45° field of view; color fundus image; 2048x1536
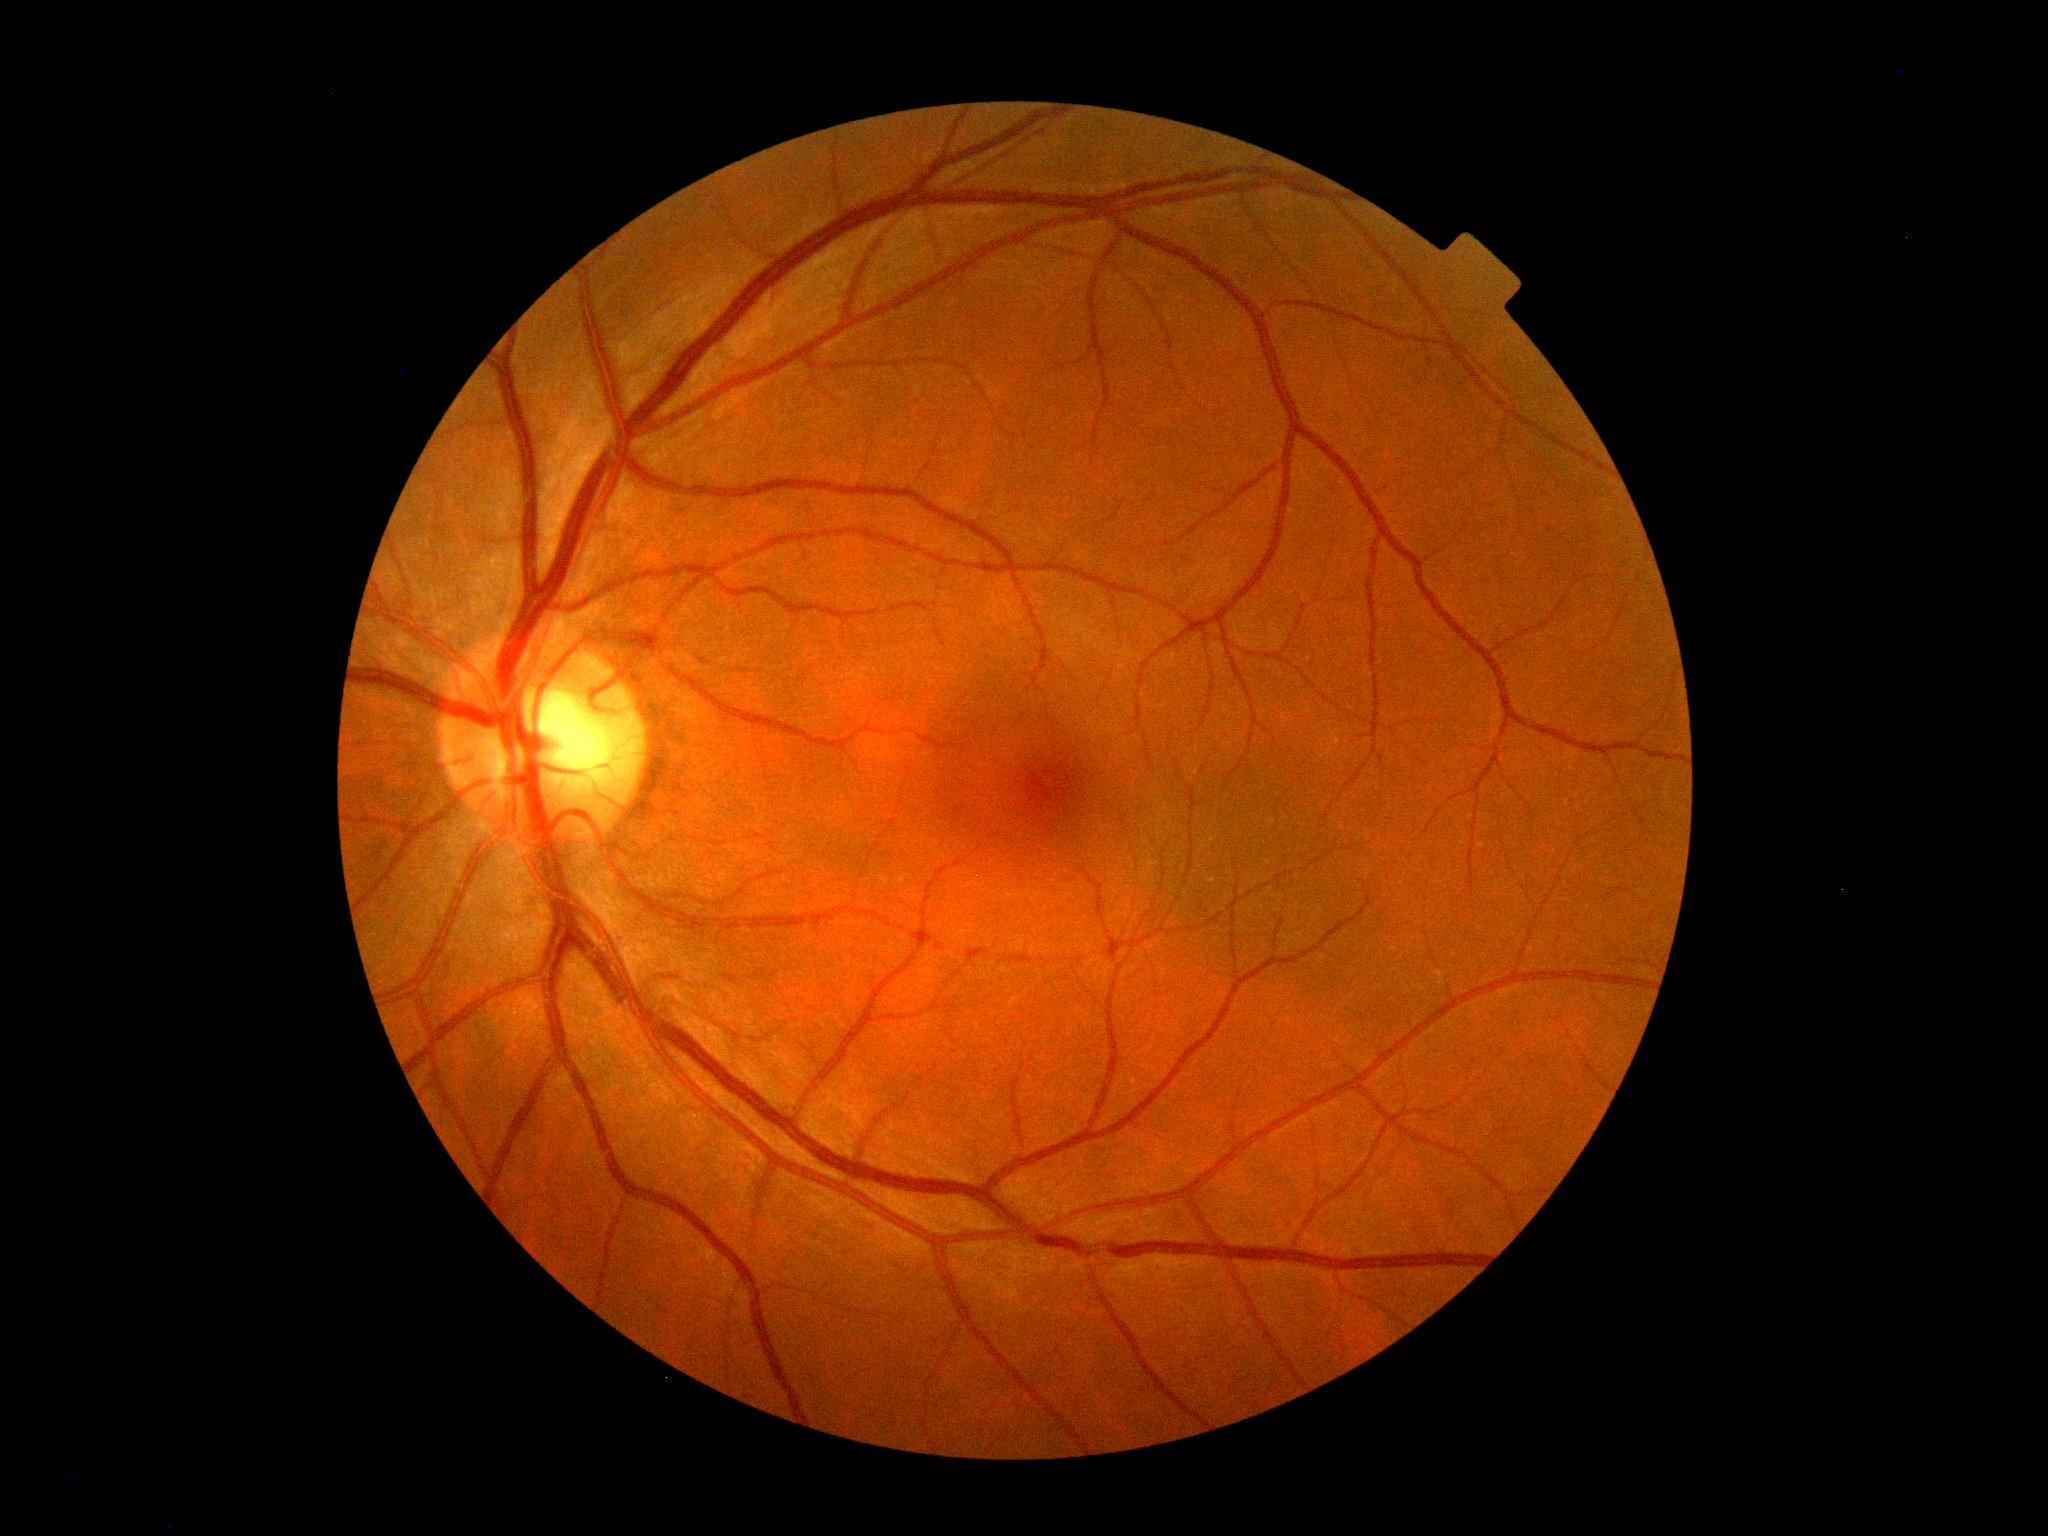 DR grade: 0 (no apparent retinopathy).